FOV: 50 degrees; captured after pupil dilation; macula at the center of the field:
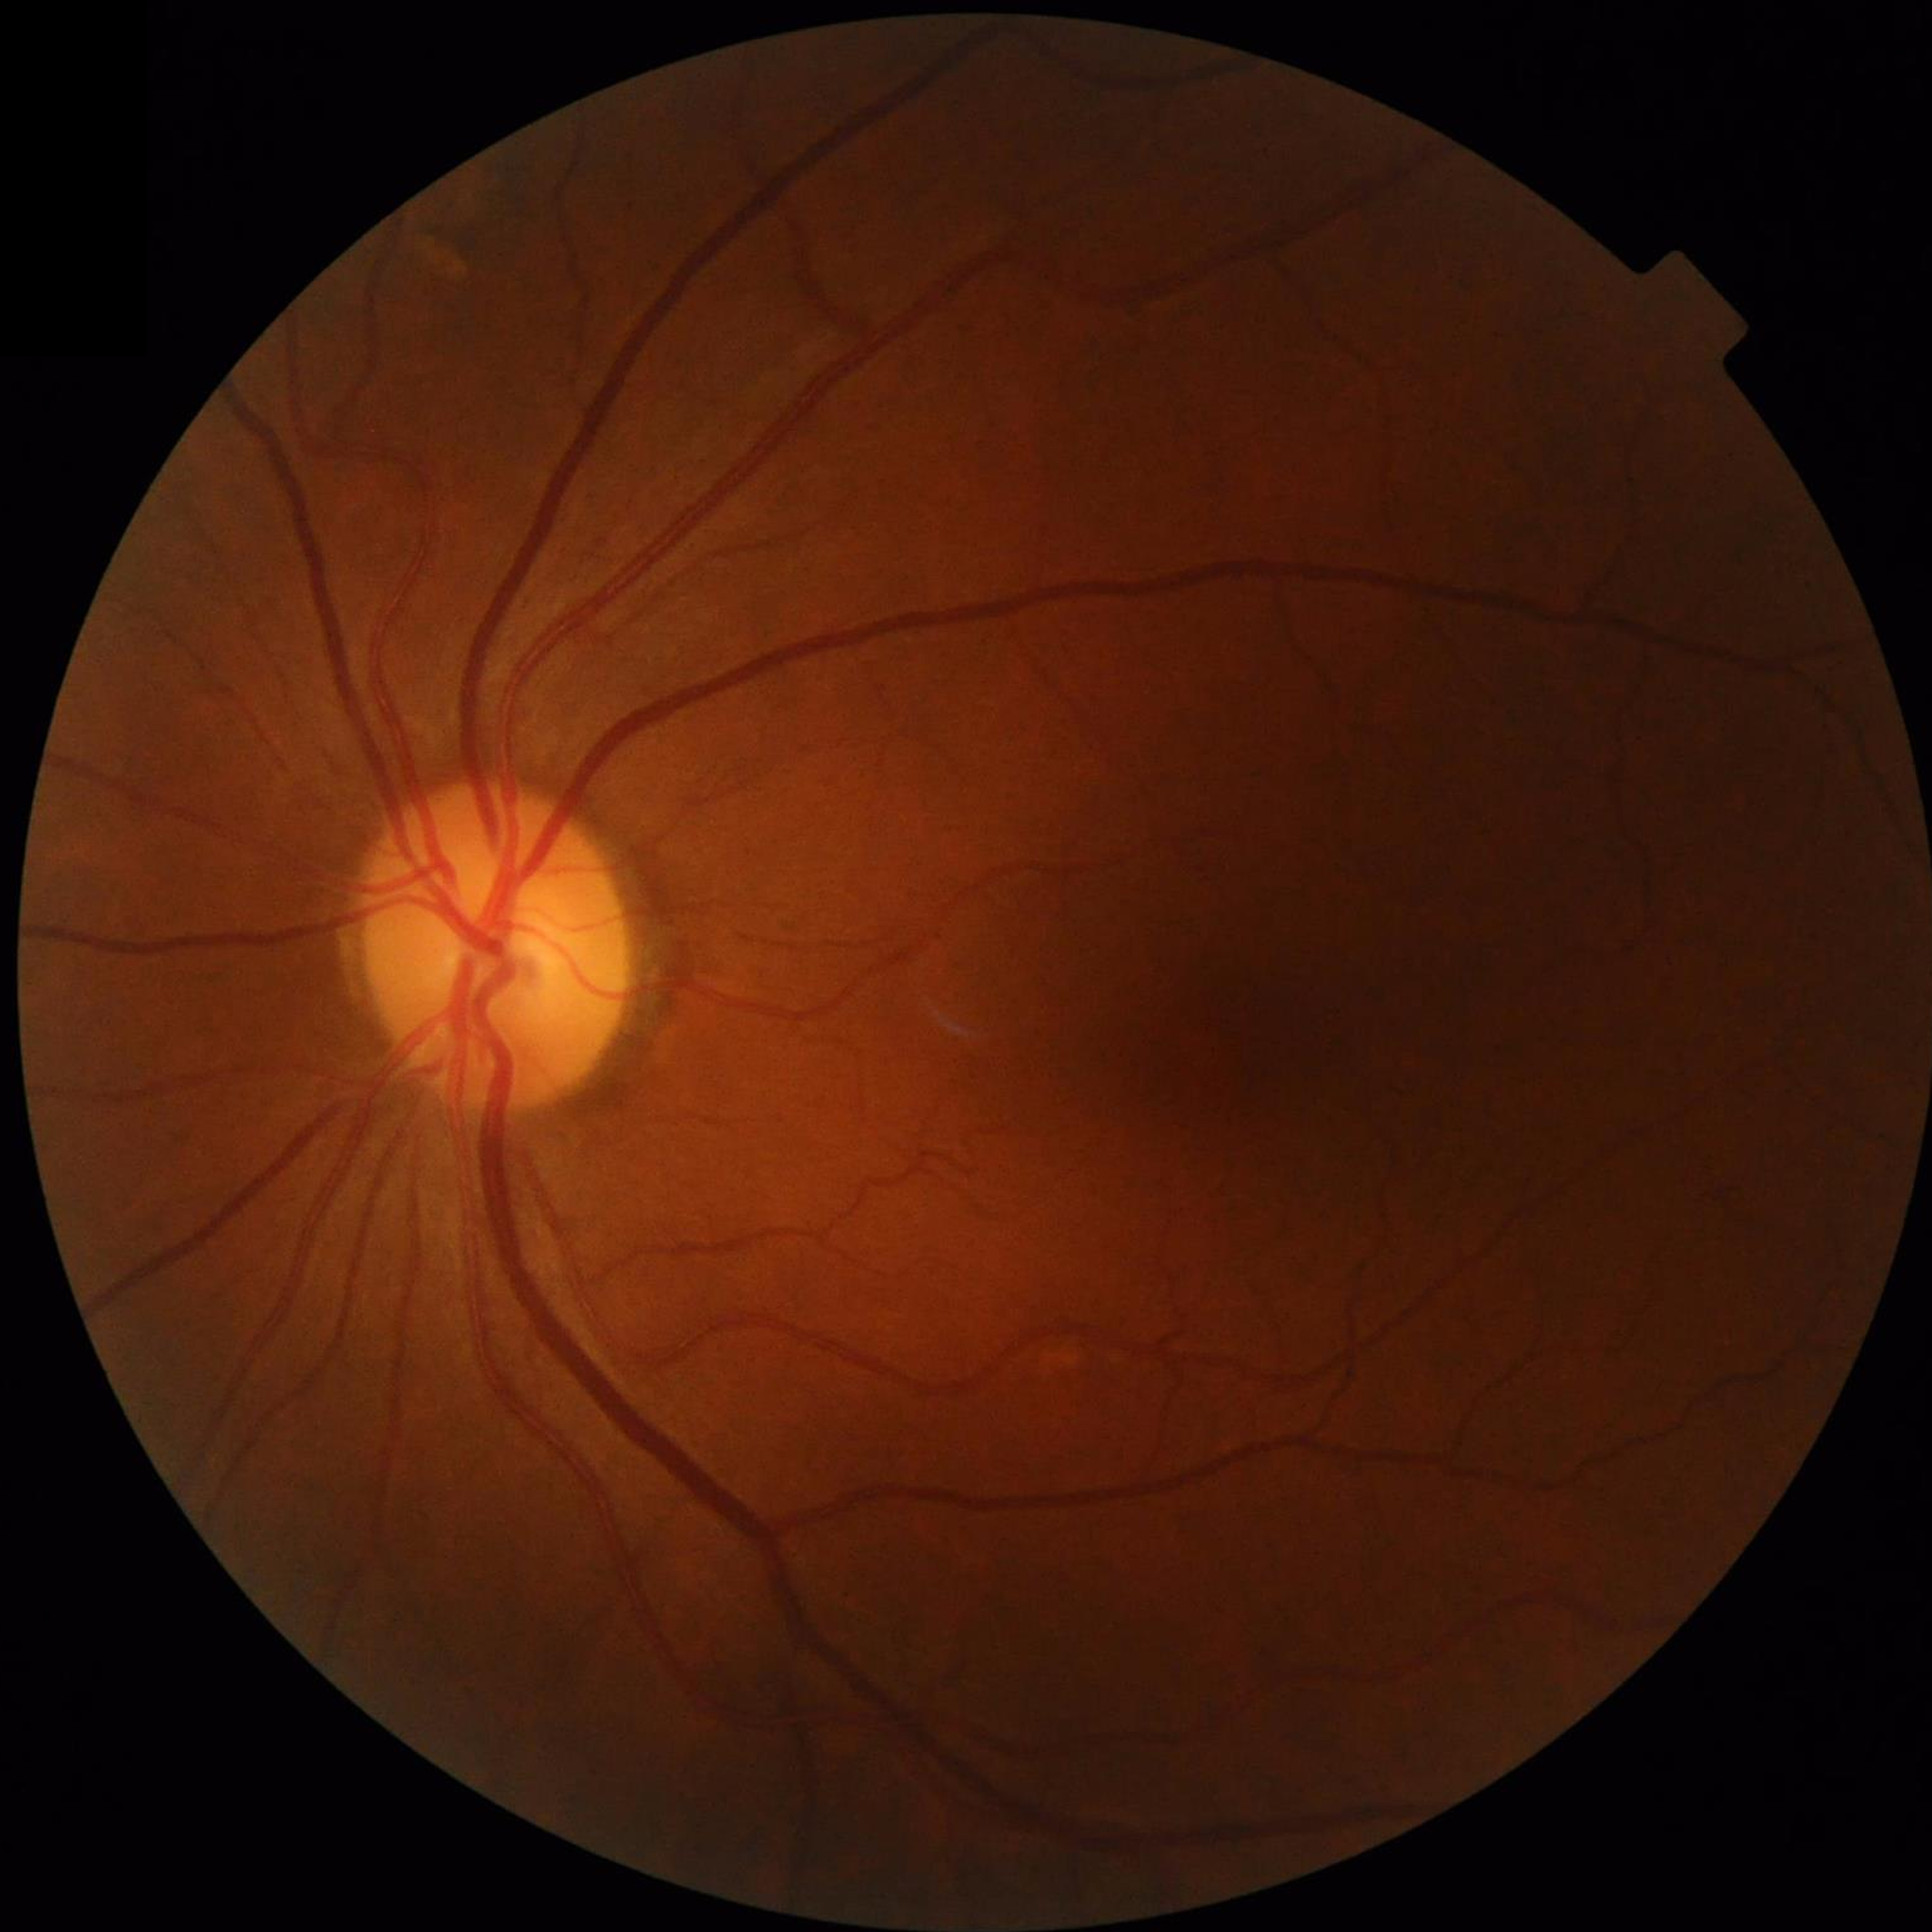

Disease class: no AMD, diabetic retinopathy, or glaucoma.